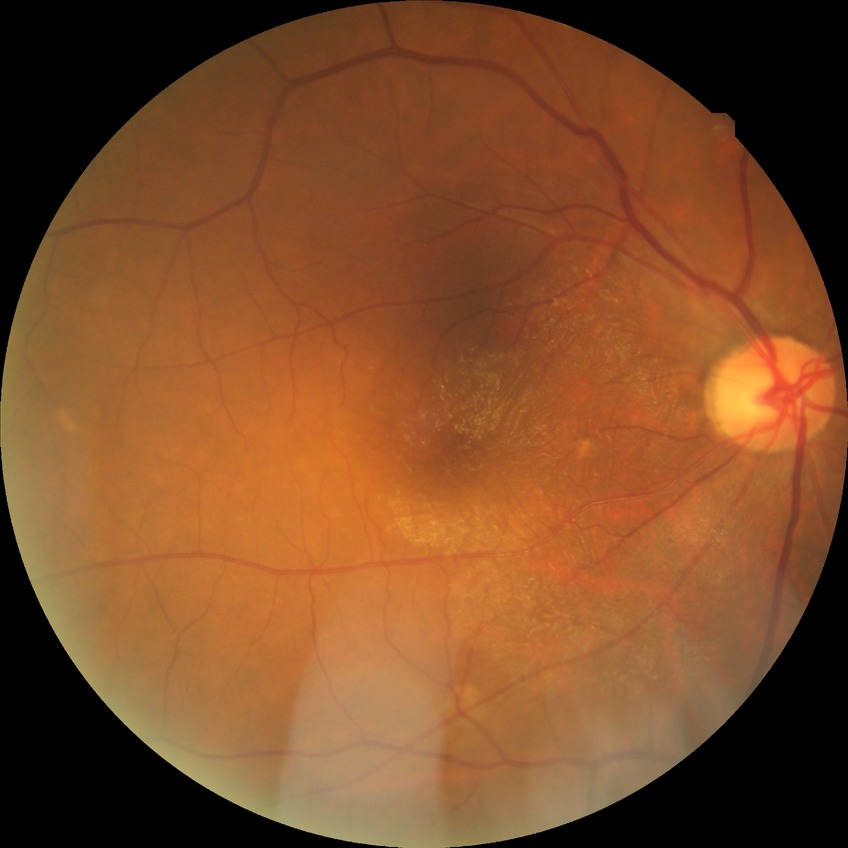

{
  "davis_grade": "no diabetic retinopathy"
}